848x848px; NIDEK AFC-230:
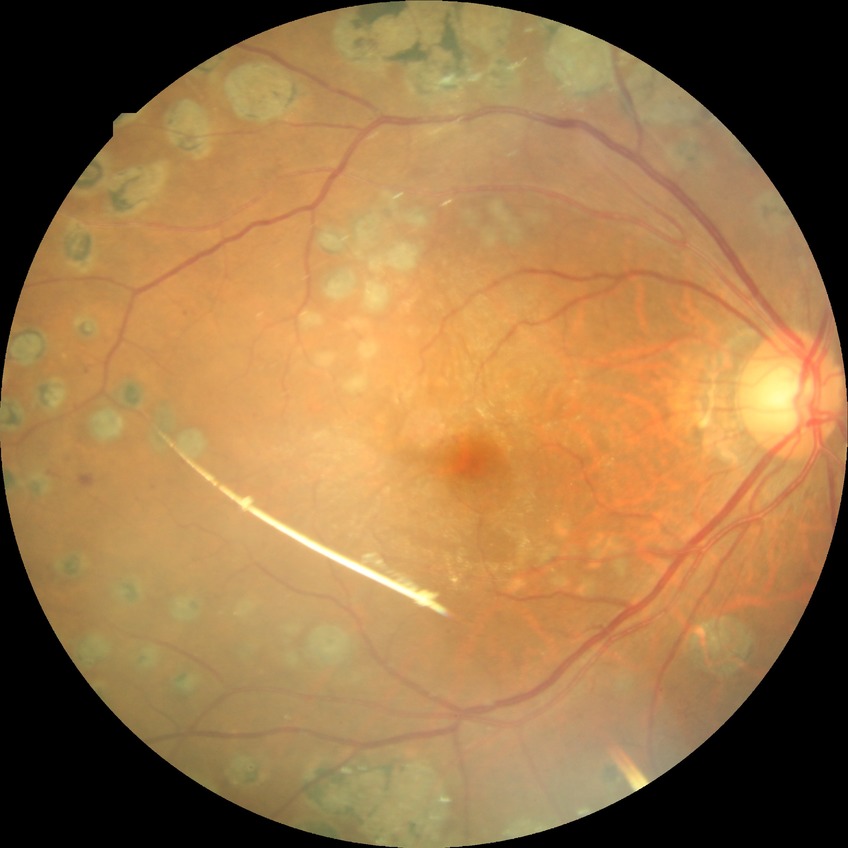
Diabetic retinopathy (DR) is PDR (proliferative diabetic retinopathy).